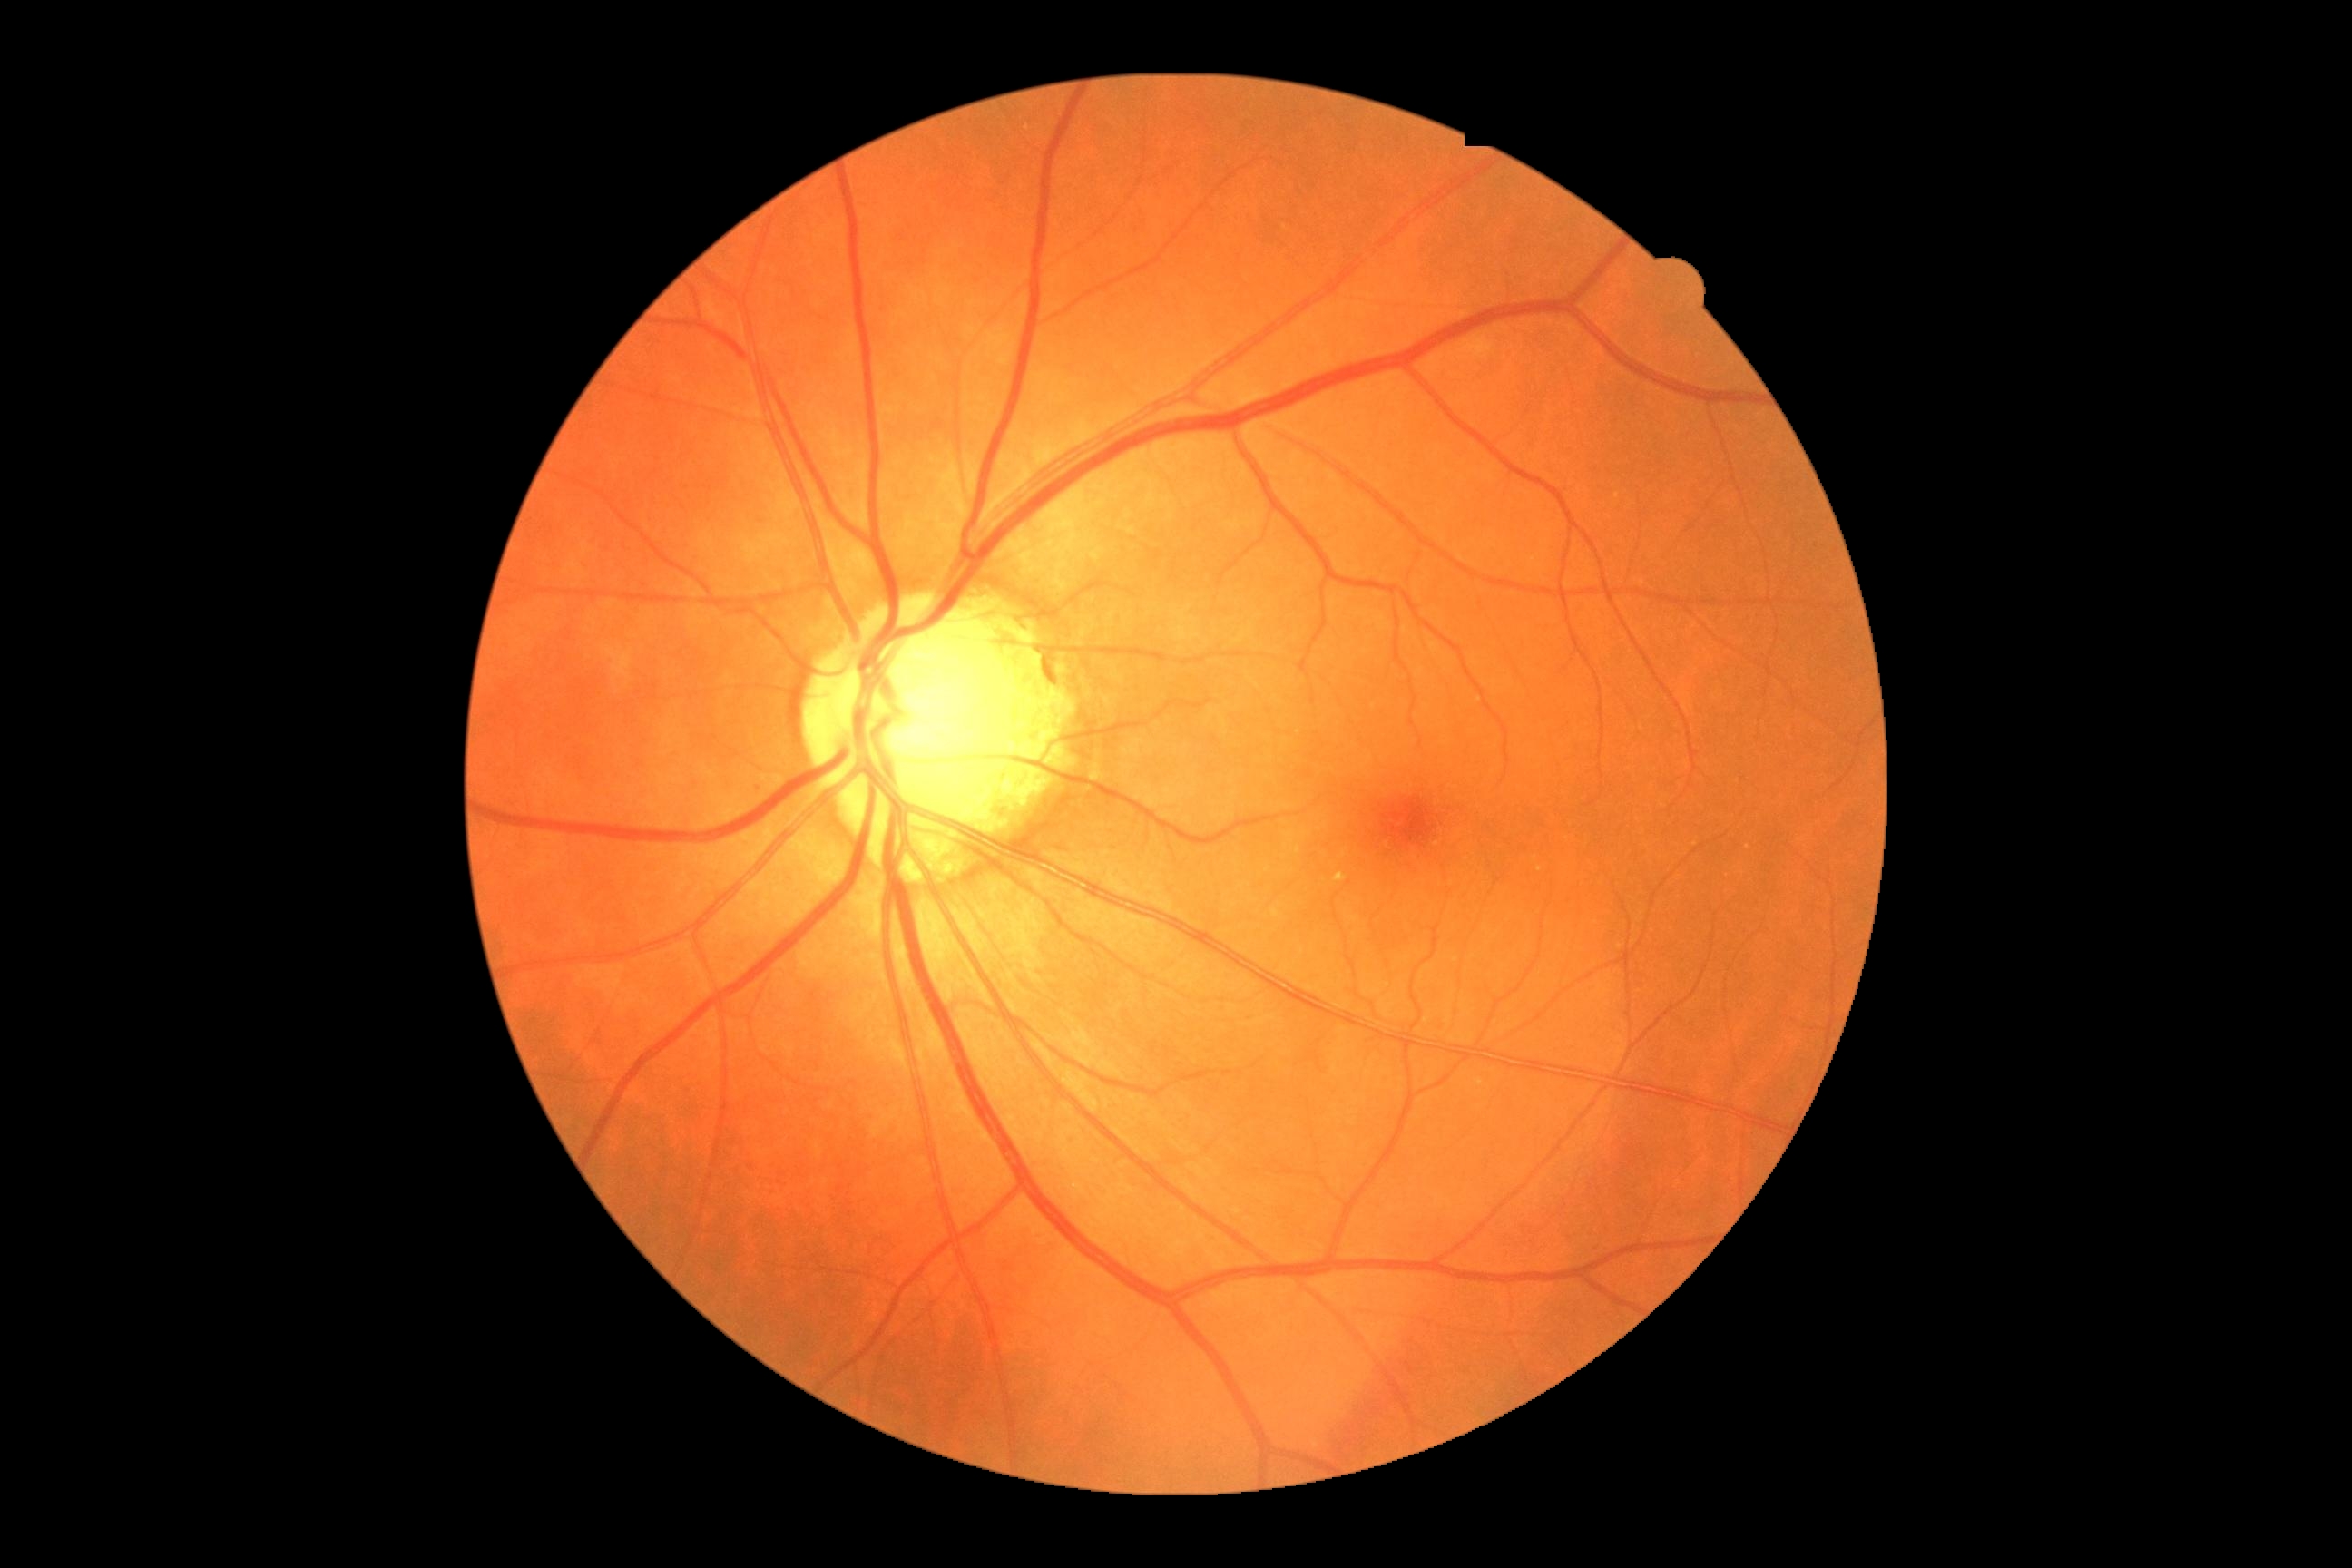

{"dr_category": "non-proliferative diabetic retinopathy", "dr_grade": "grade 2 (moderate NPDR)"}